Fundus photo:
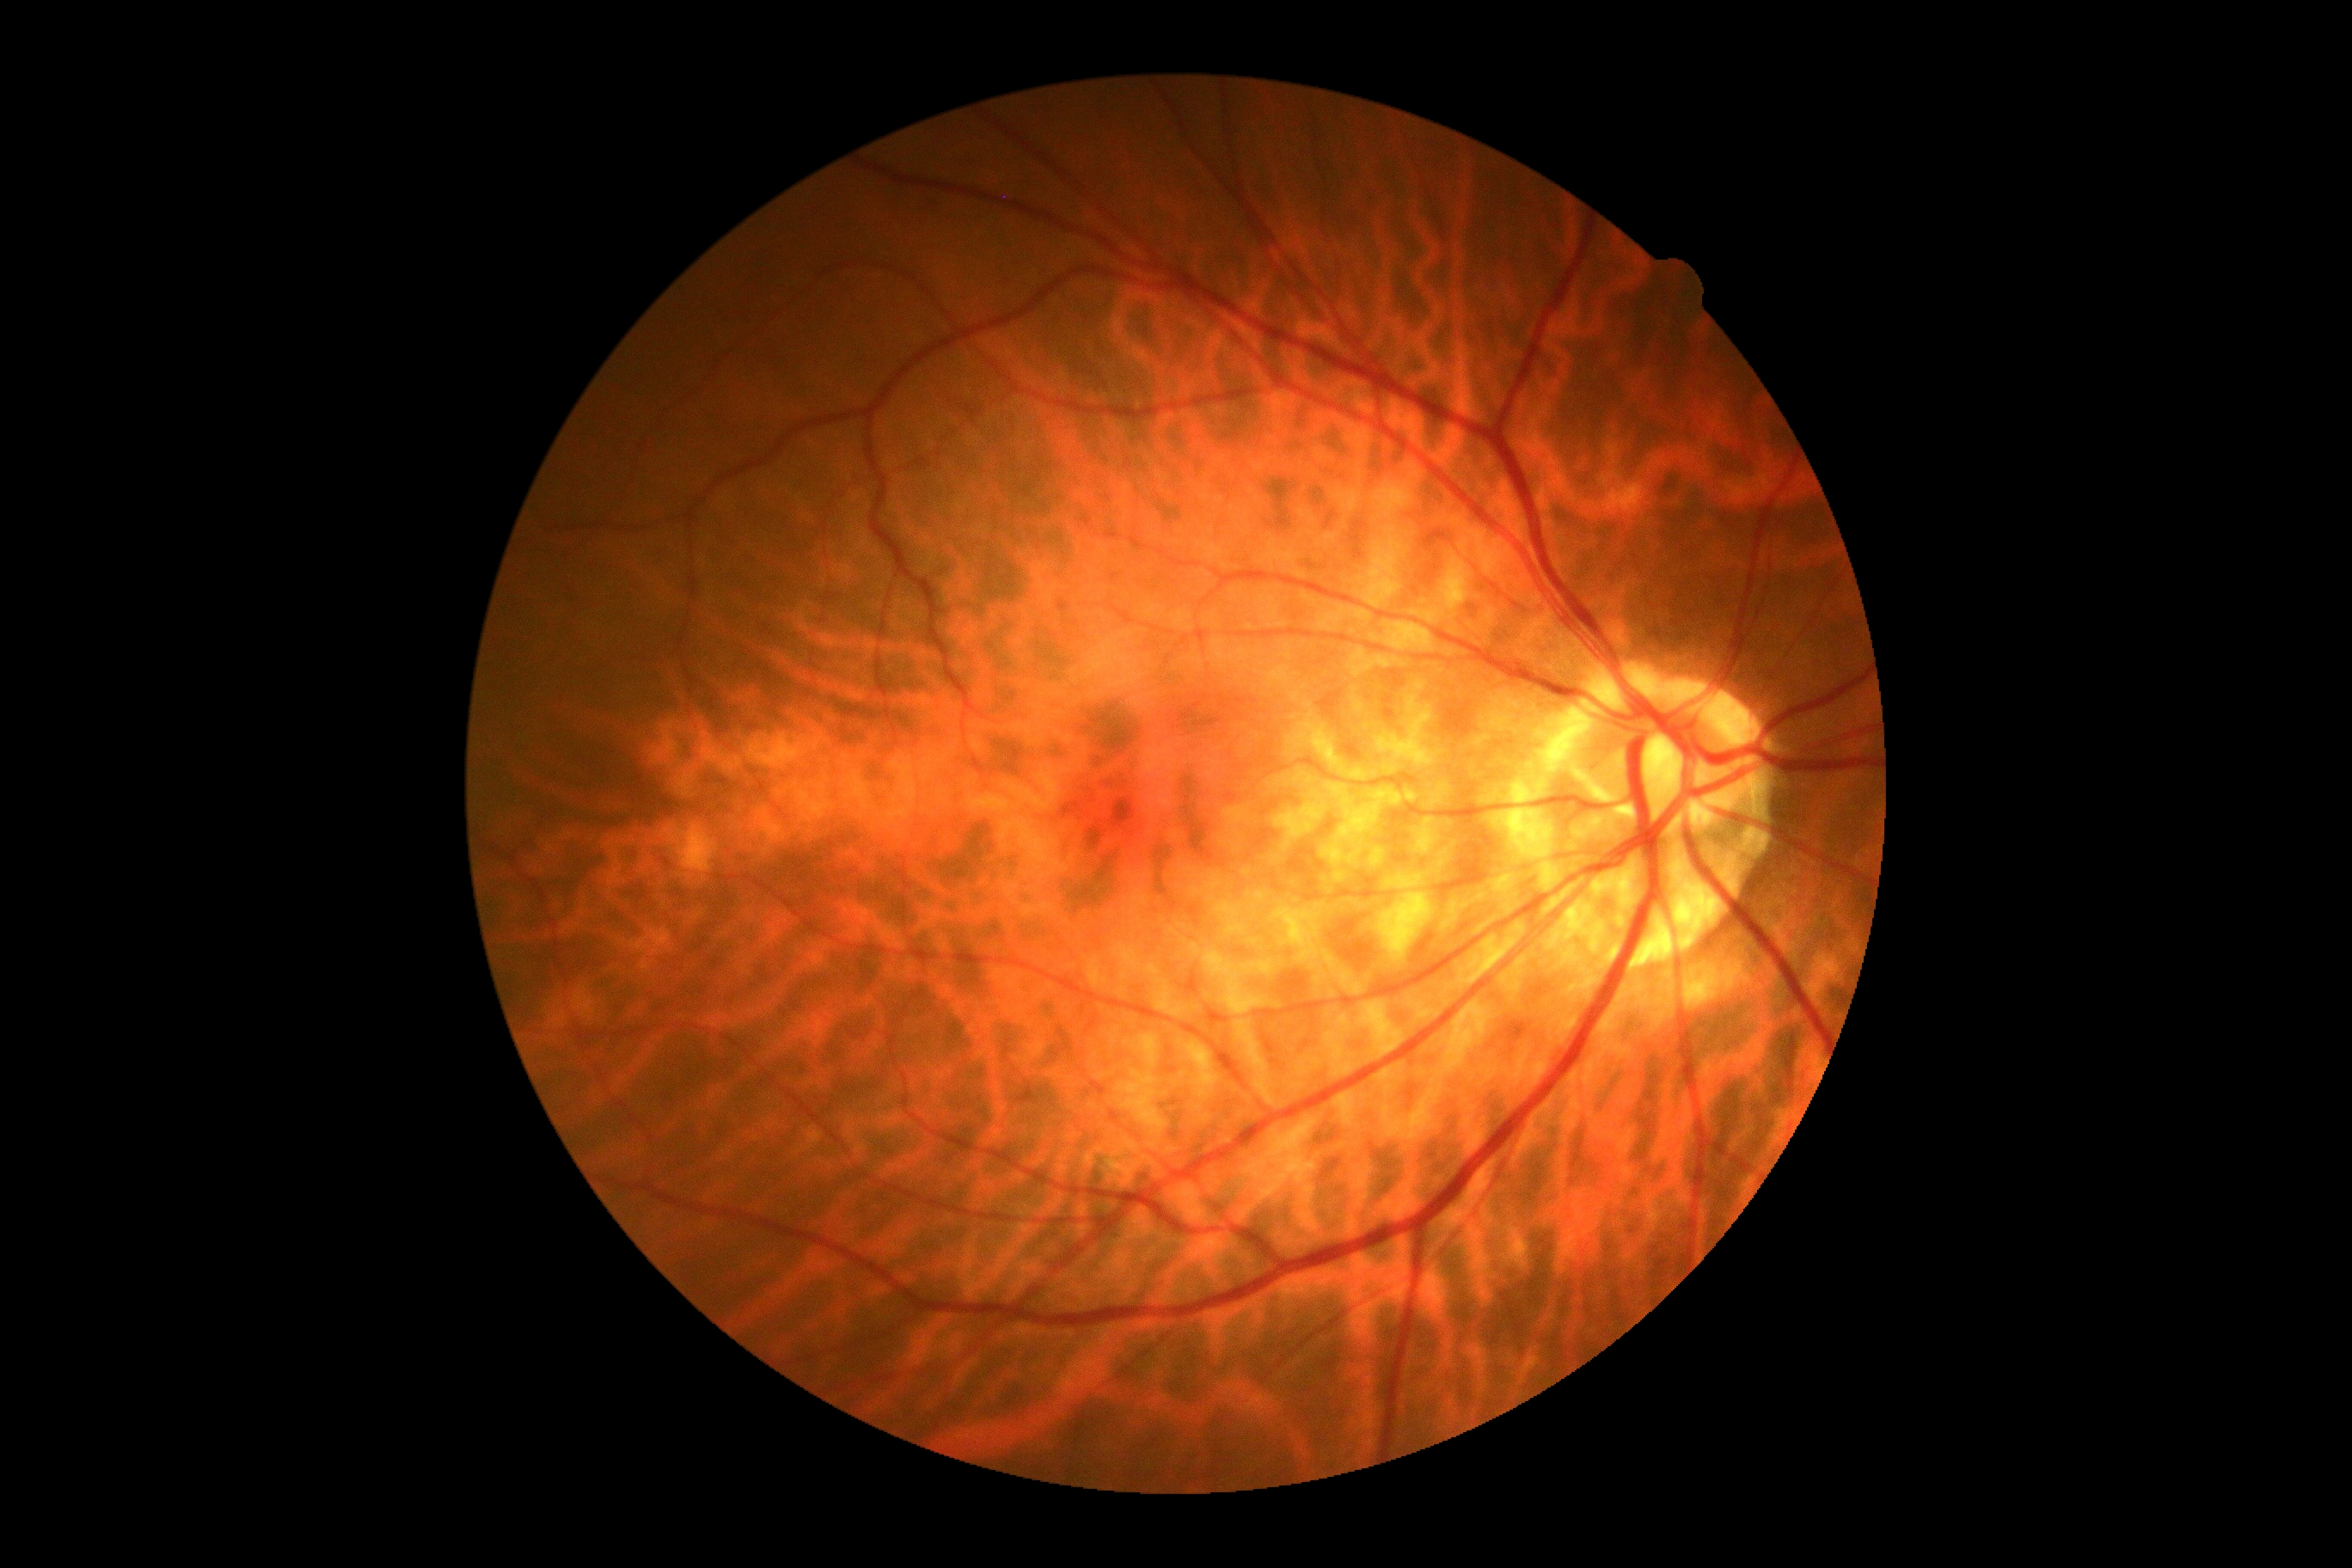

No DR findings. DR severity: grade 0.